Image size 848x848. Fundus photo:
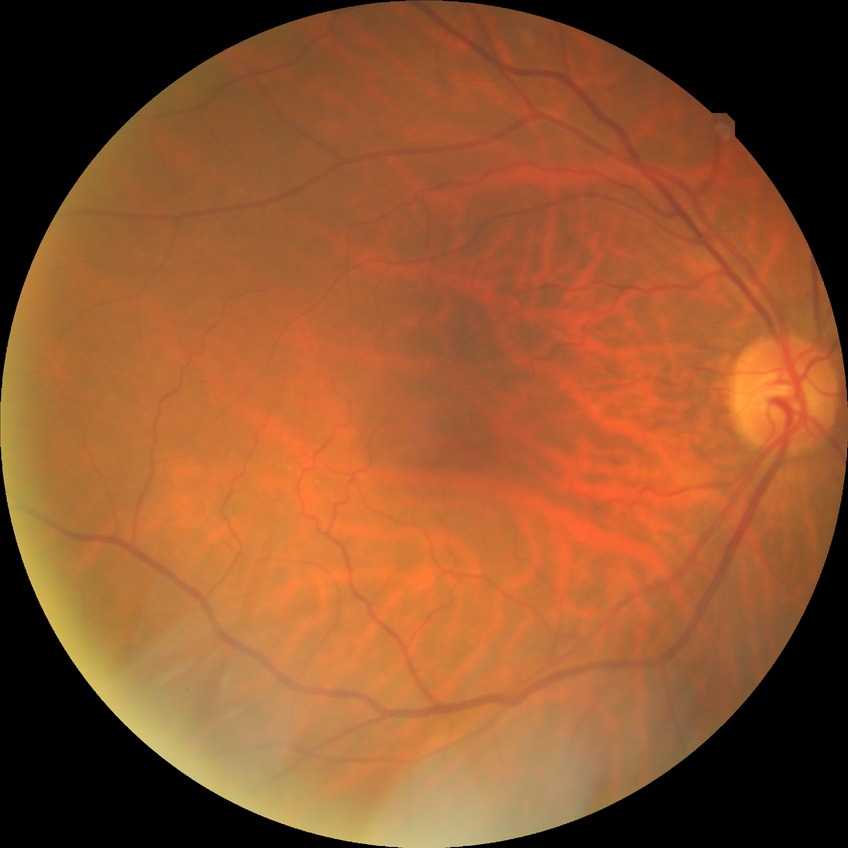

Retinopathy stage is no diabetic retinopathy.